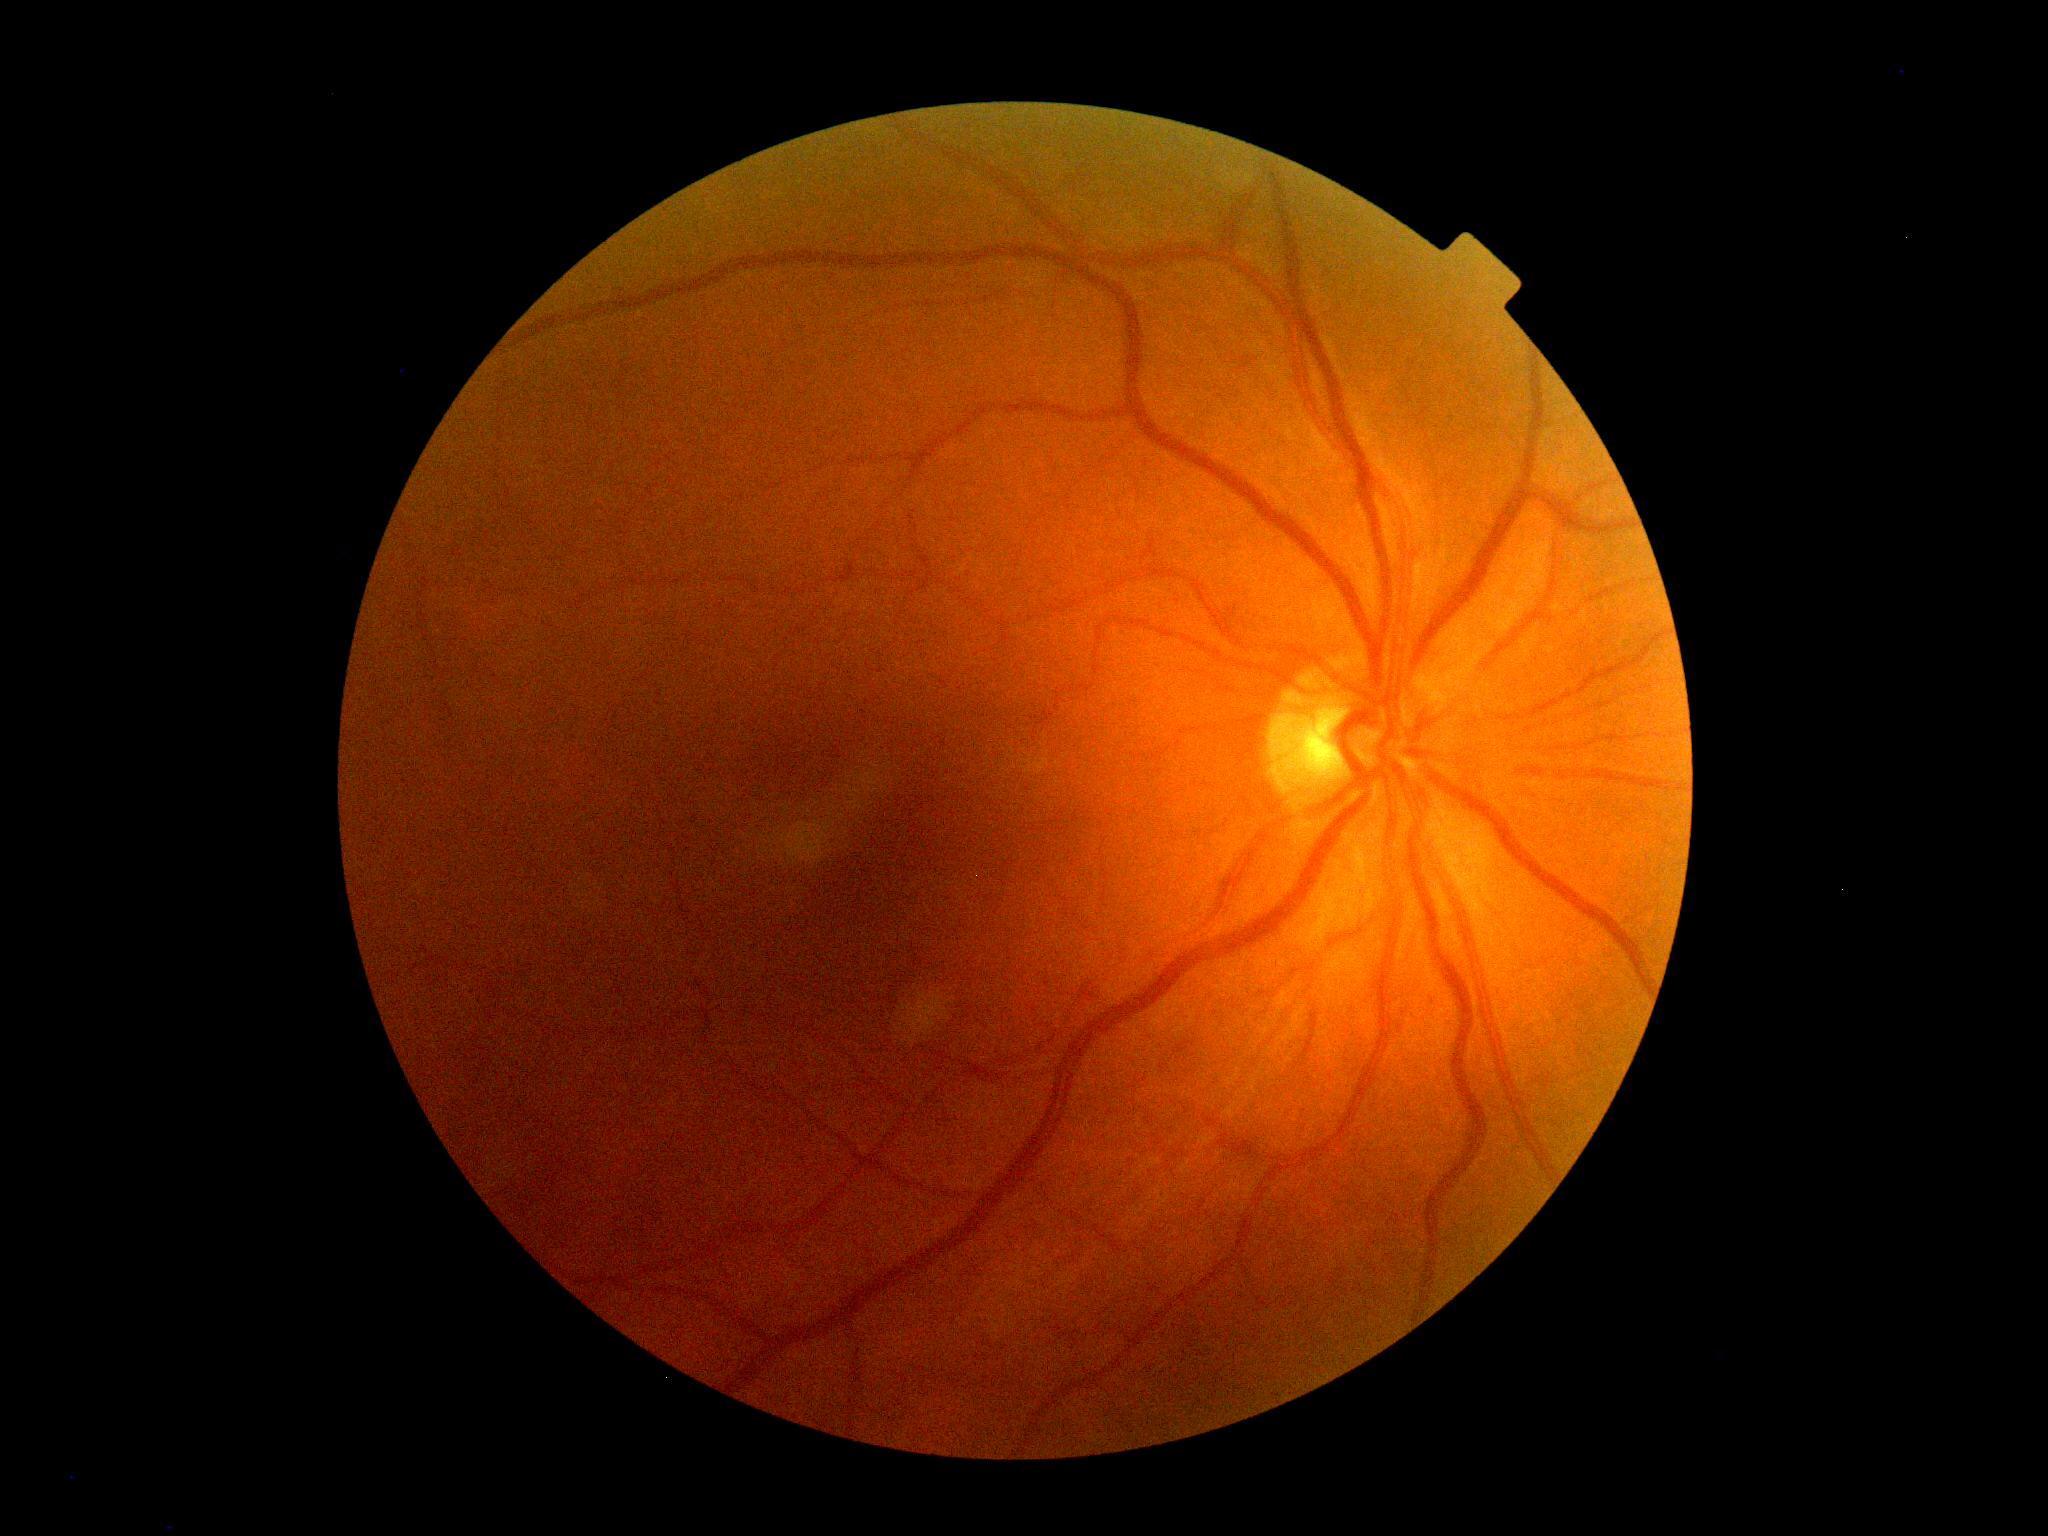 DR stage: no apparent retinopathy (grade 0).